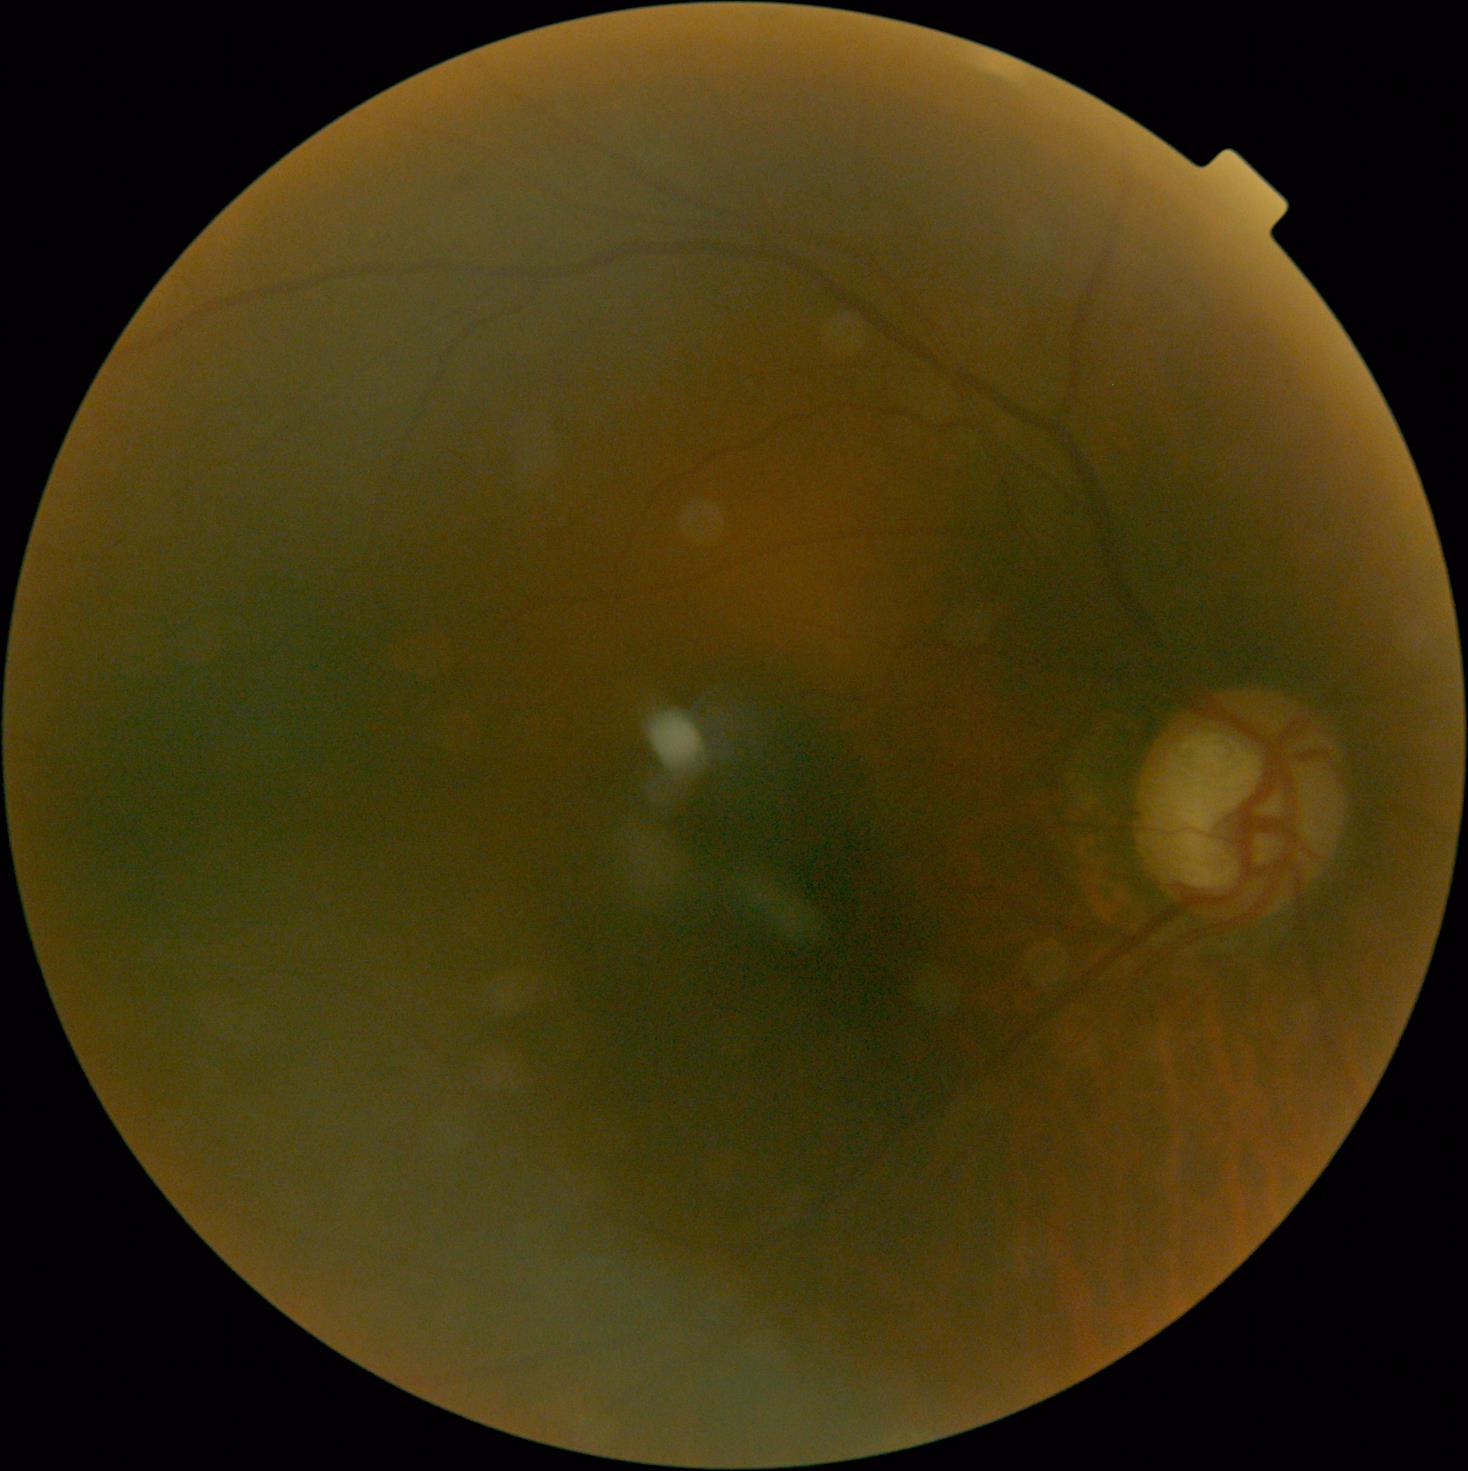
Diabetic retinopathy grade: 0 (no apparent retinopathy) — no visible signs of diabetic retinopathy.